1240 by 1240 pixels. Infant wide-field retinal image — 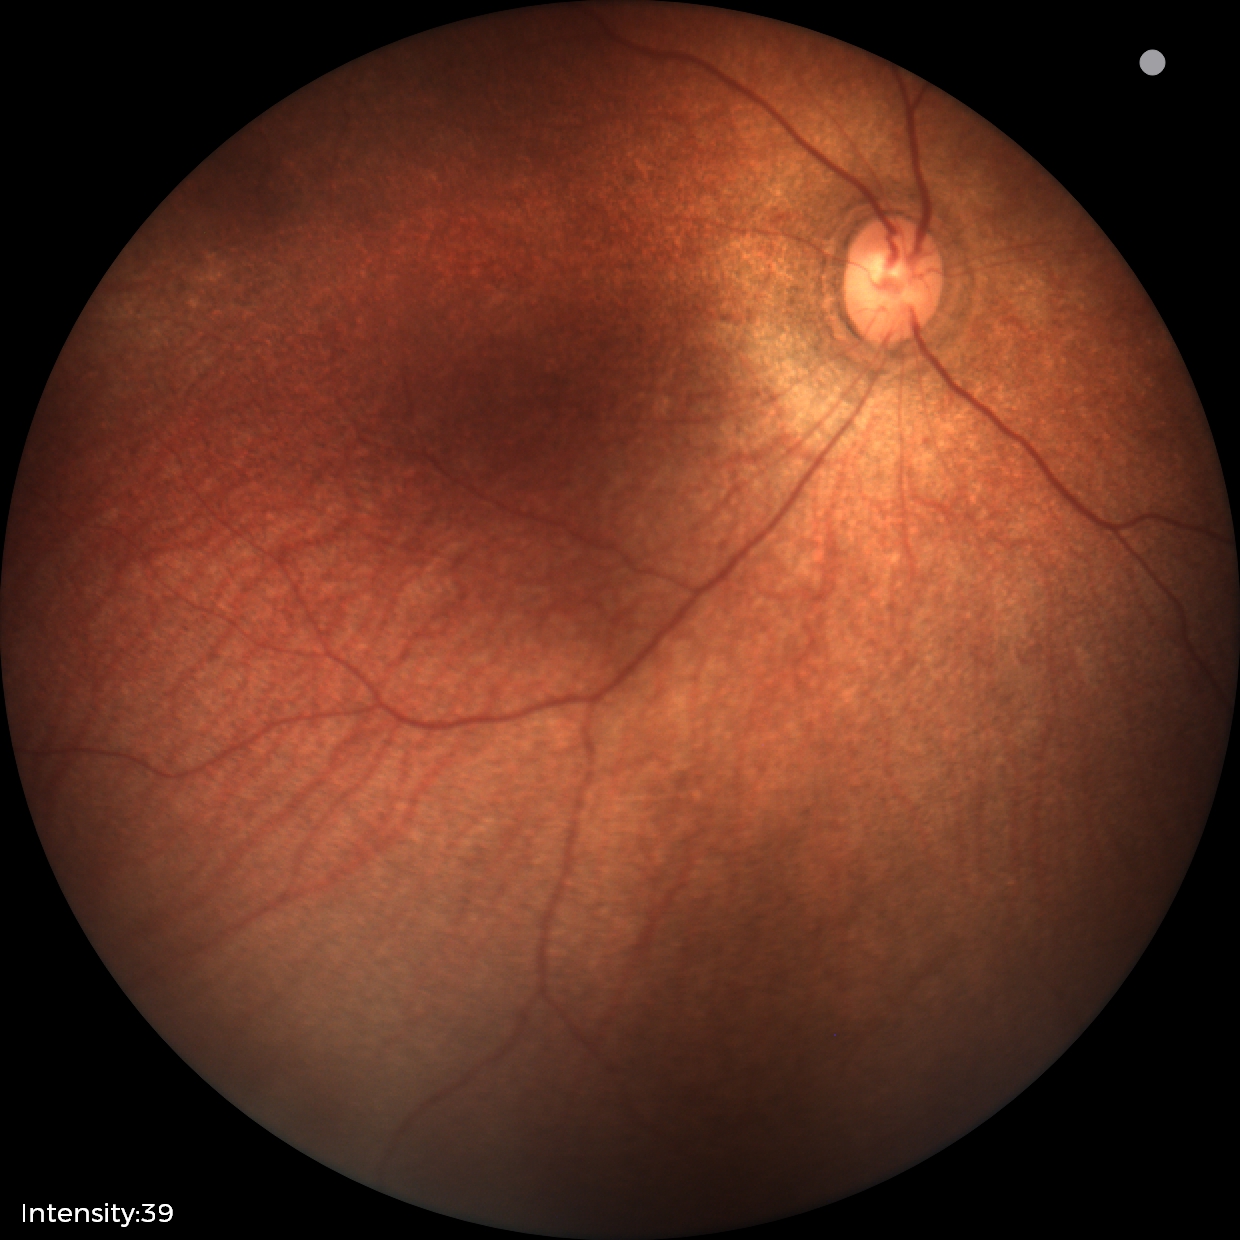

Physiological retinal appearance for postconceptual age.